1924 x 1556 pixels, ultra-widefield fundus photograph:
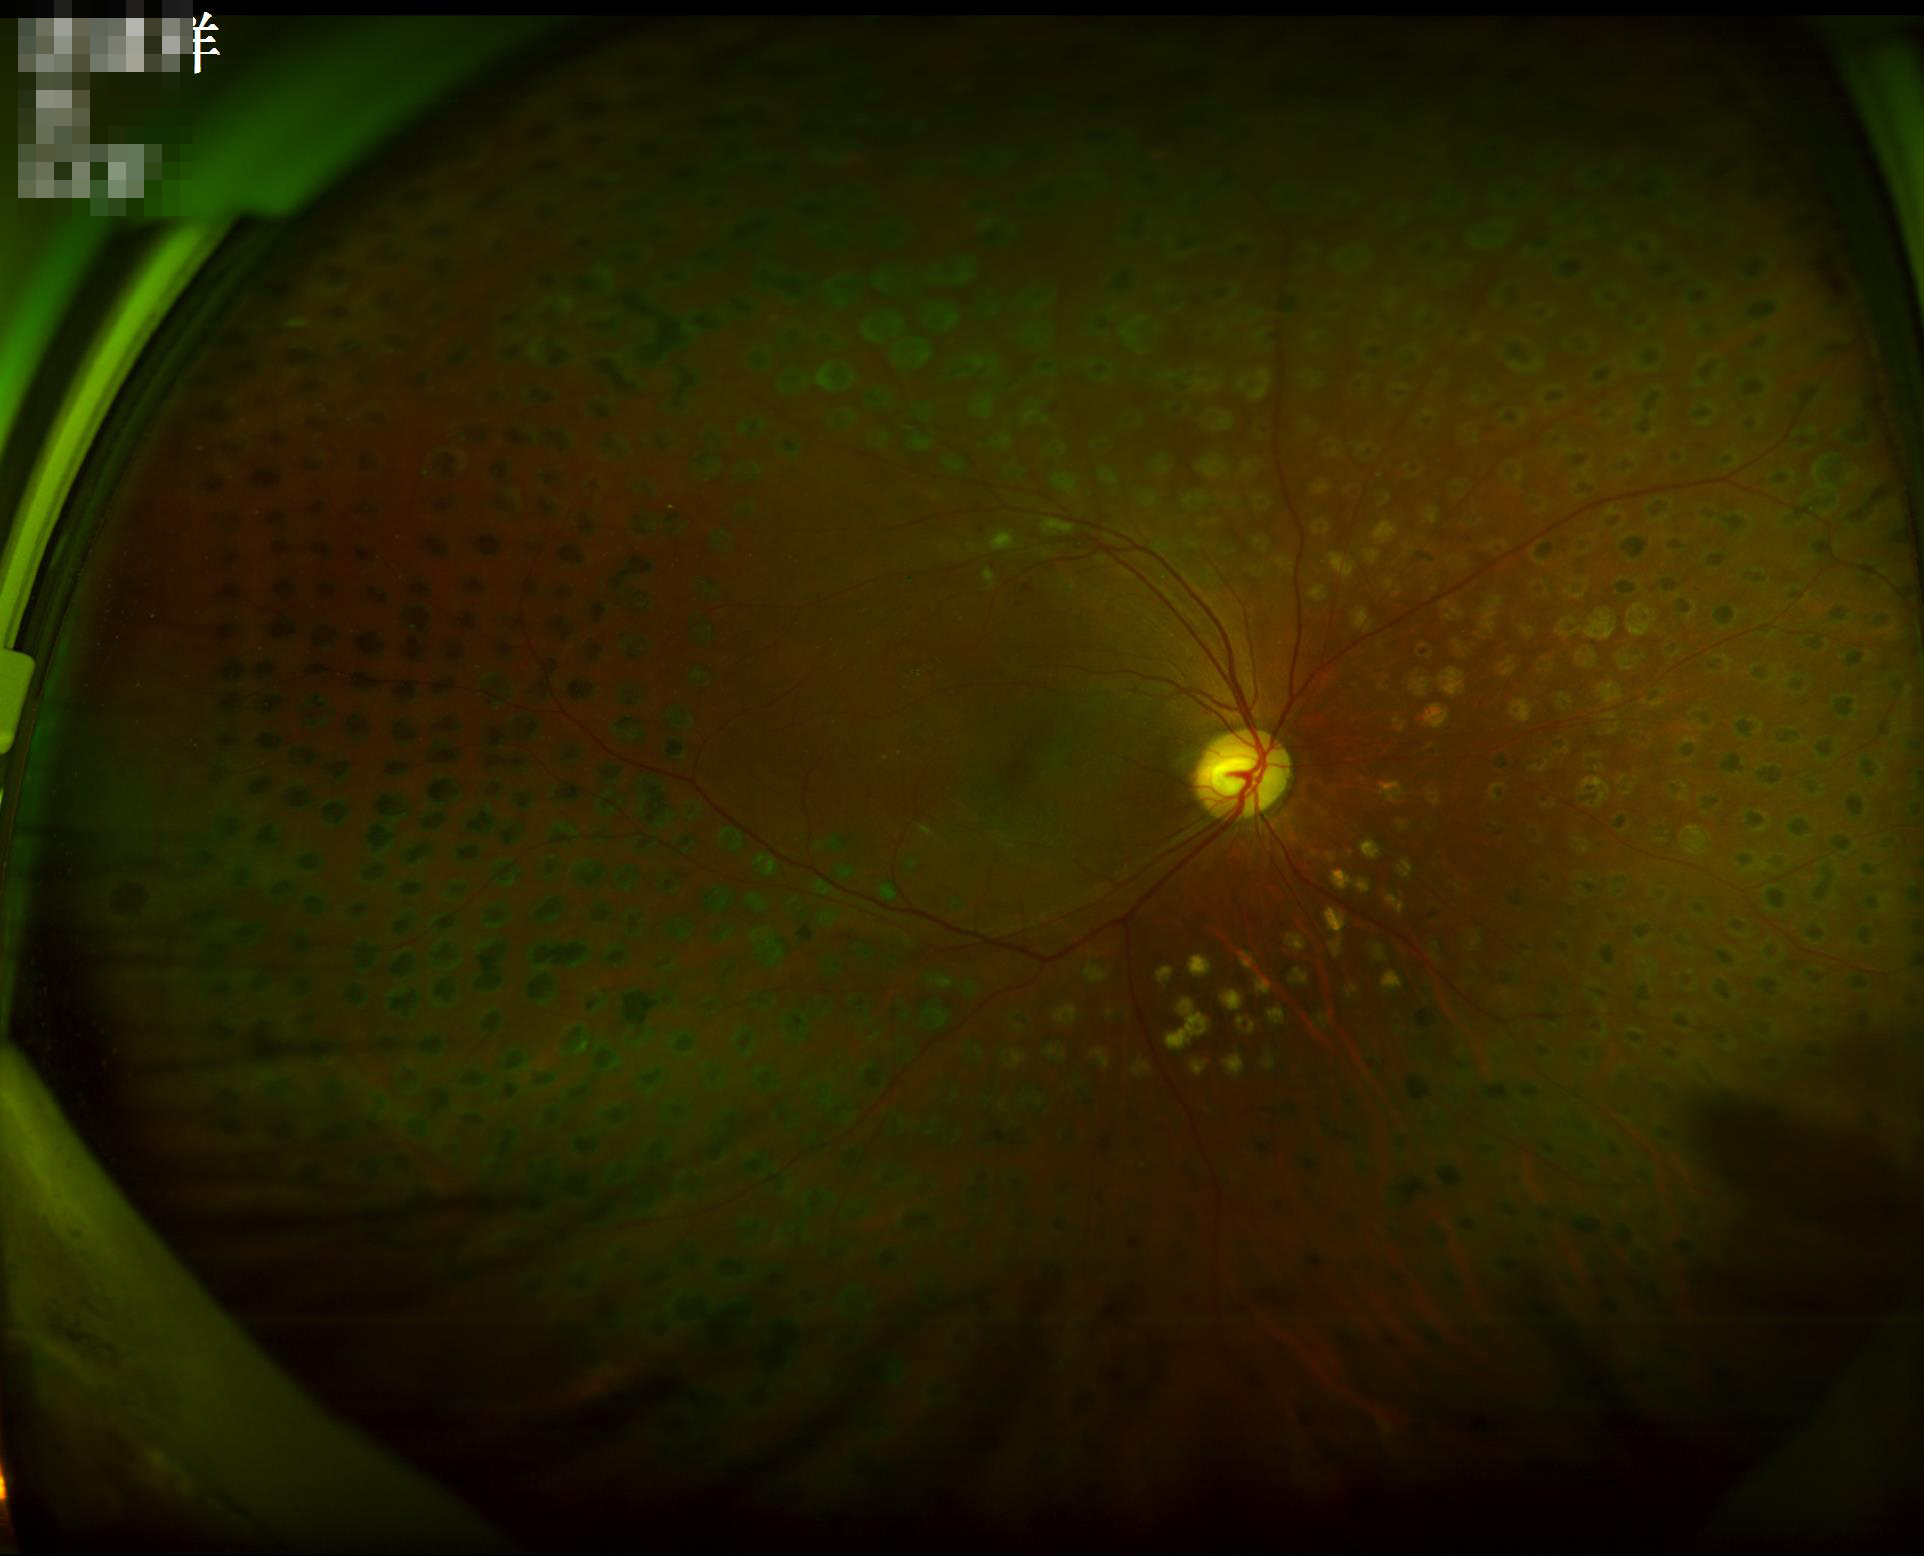 Illumination/color = uneven | Overall quality = adequate | Clarity = clear.